Fundus photo taken with a portable handheld camera:
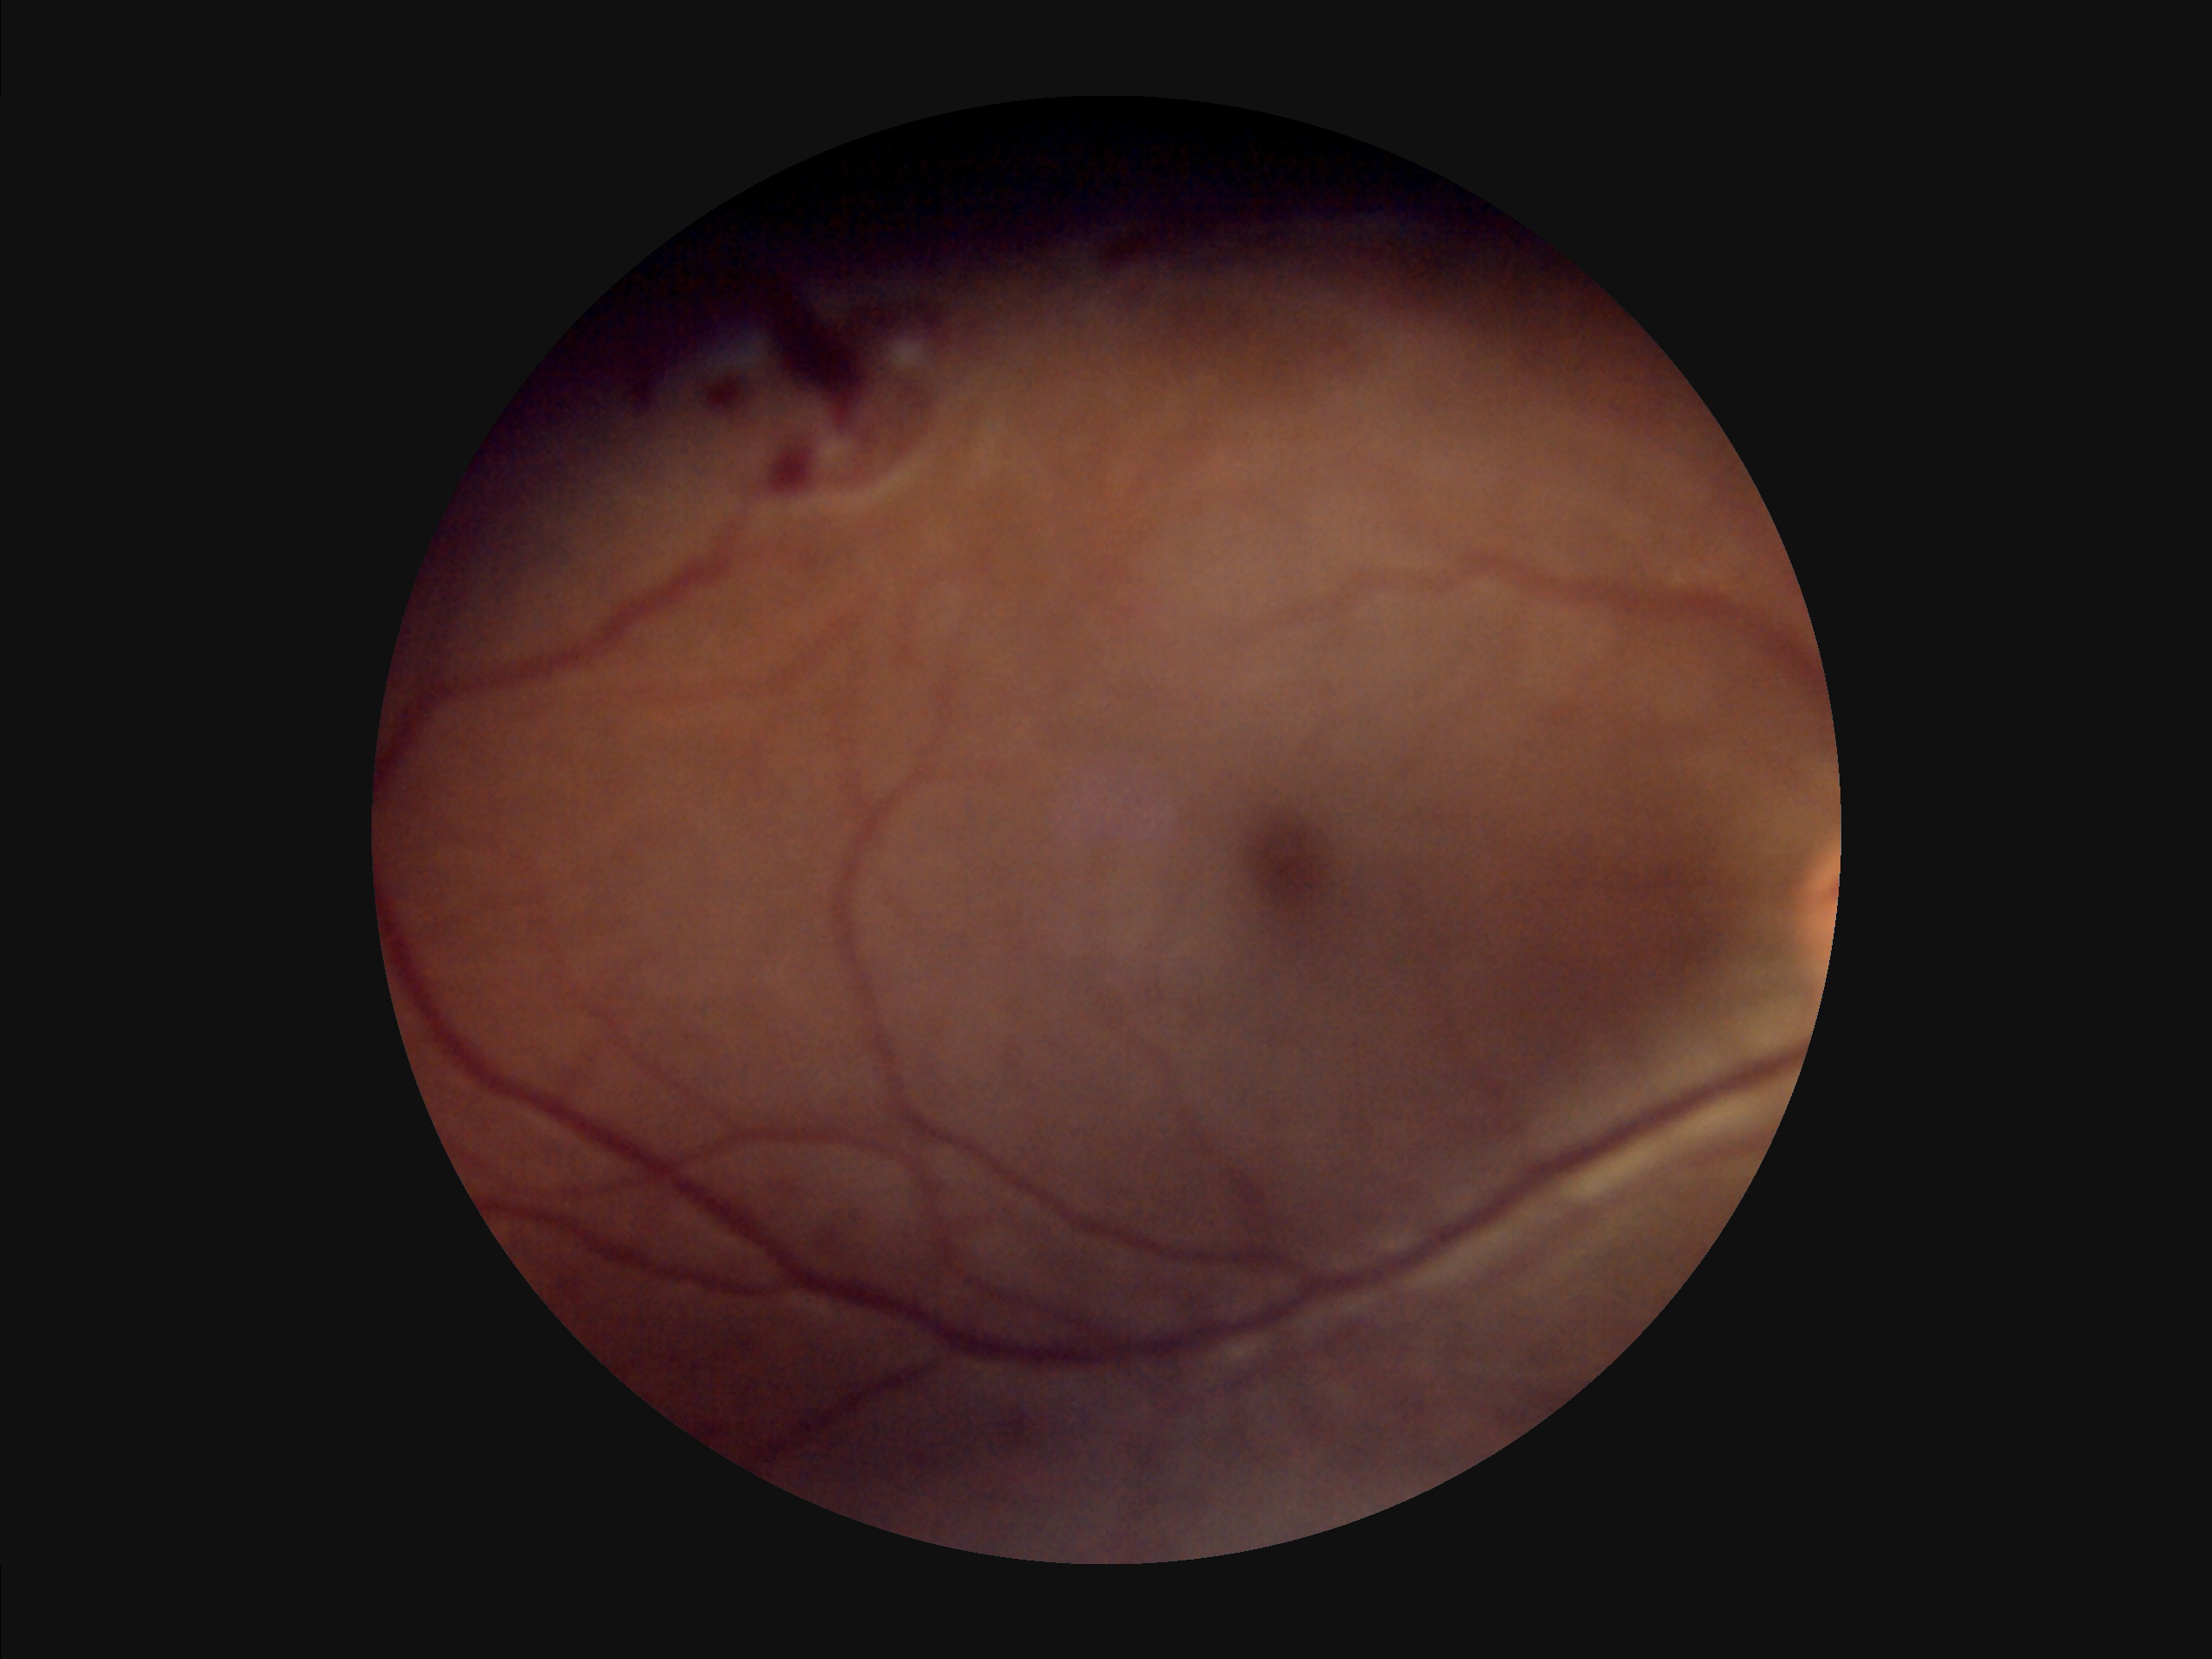 Illumination and color are suboptimal.
Noticeable blur in the optic disc, vessels, or background.
Overall quality is poor; the image is difficult to grade.
Poor dynamic range.